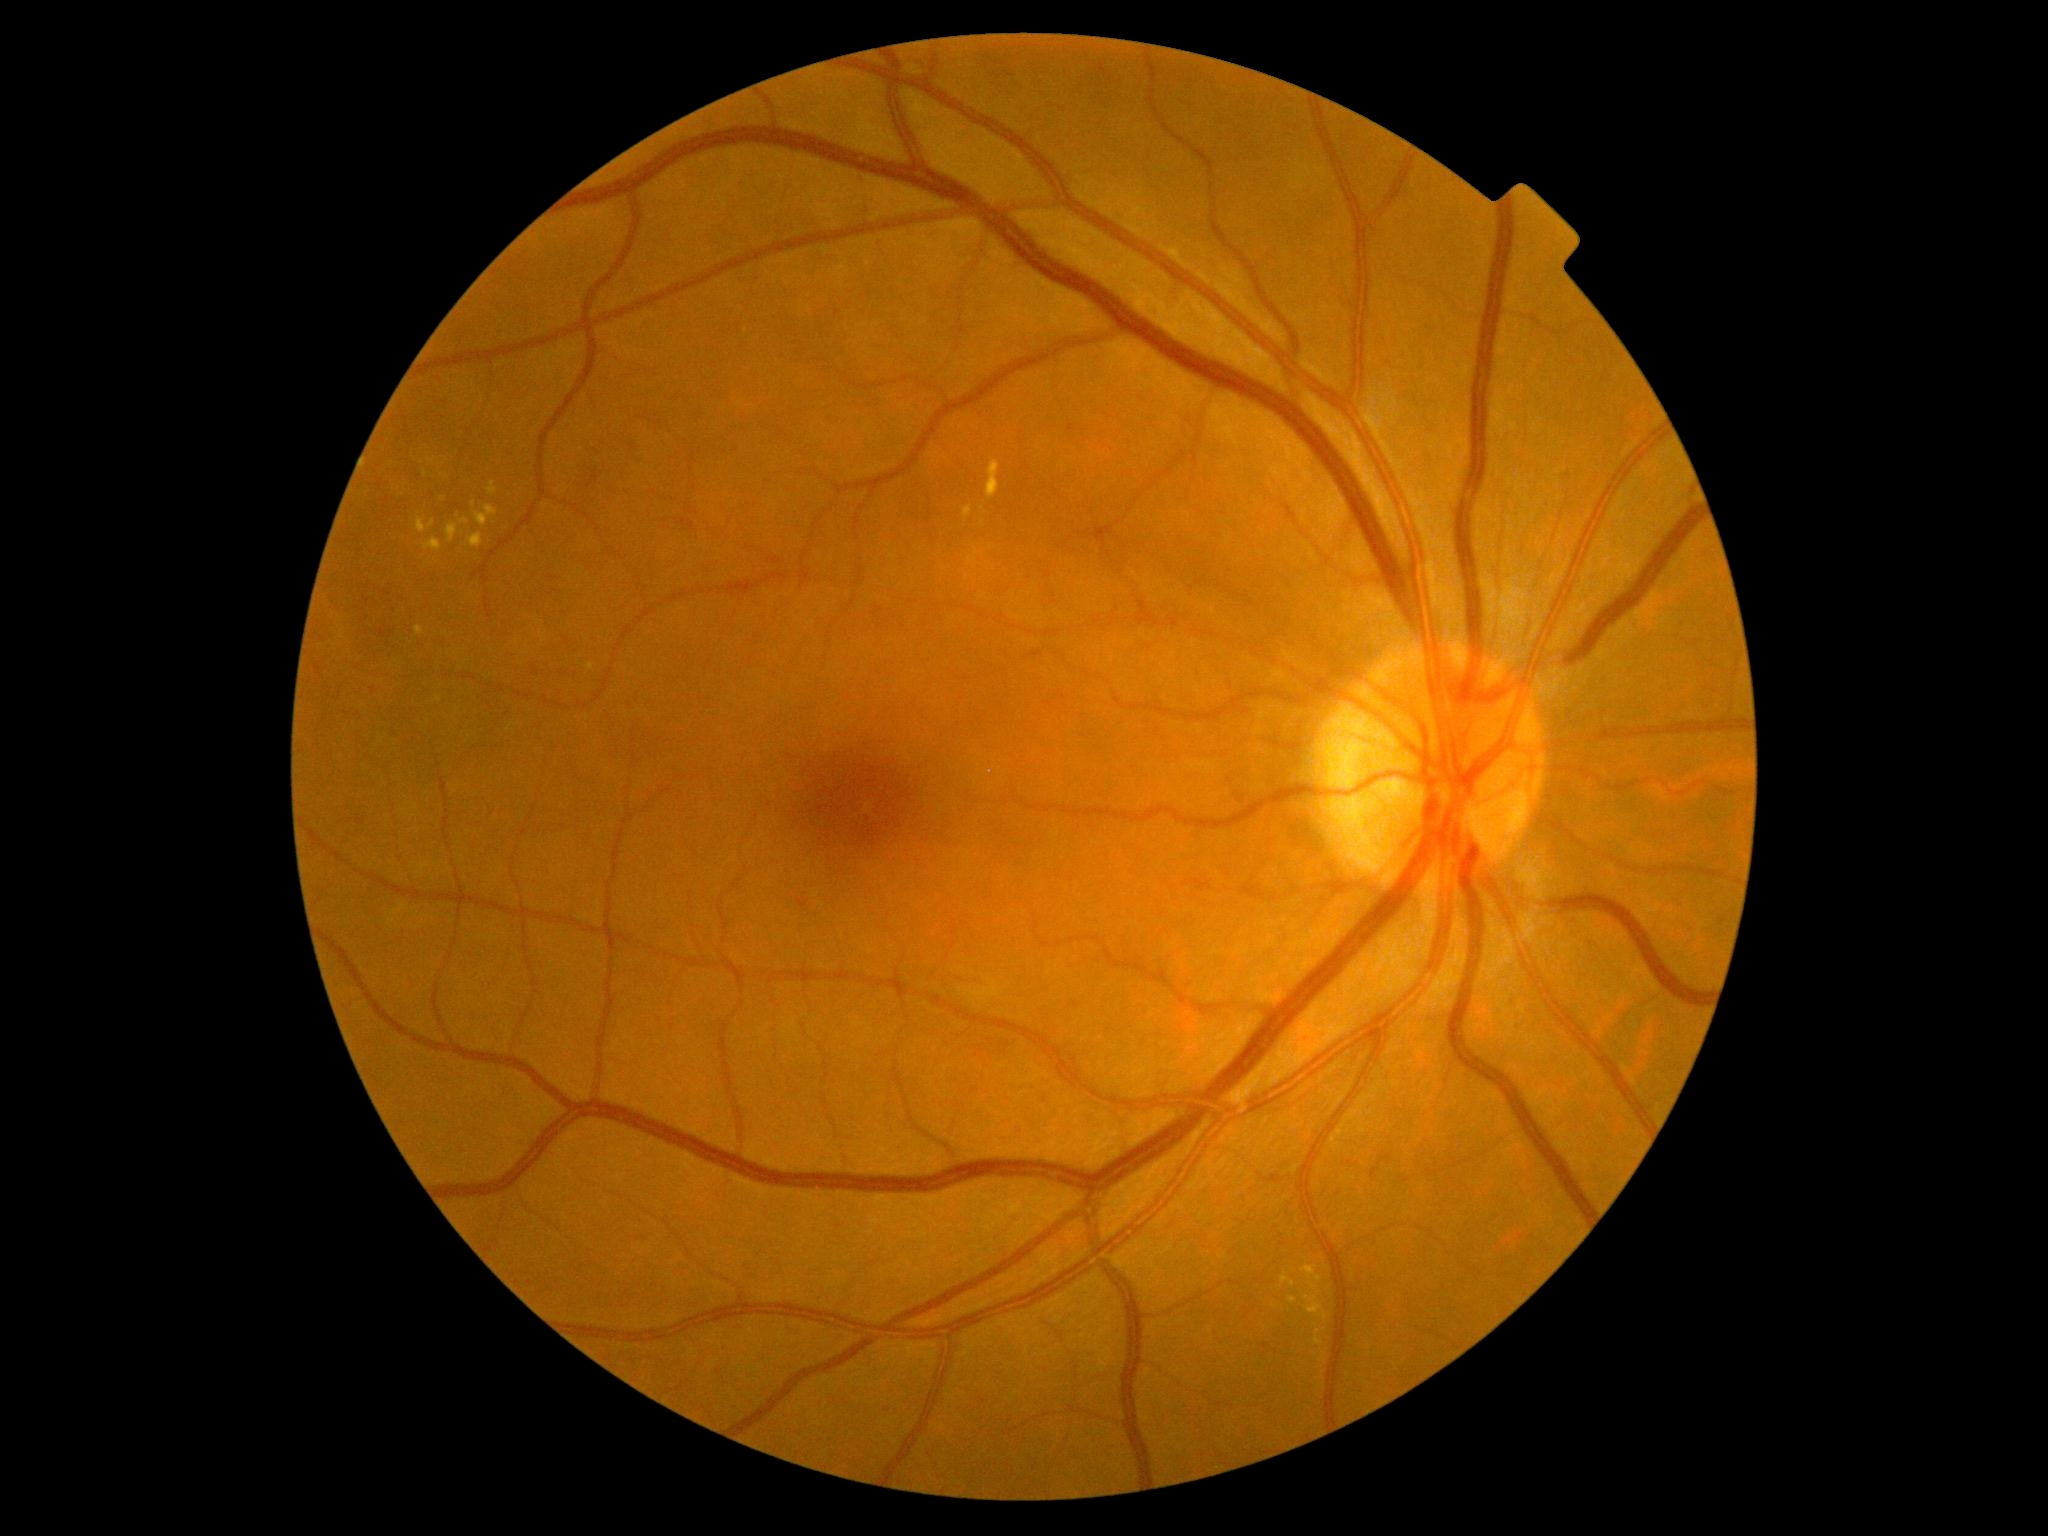 DR severity: 2/4.